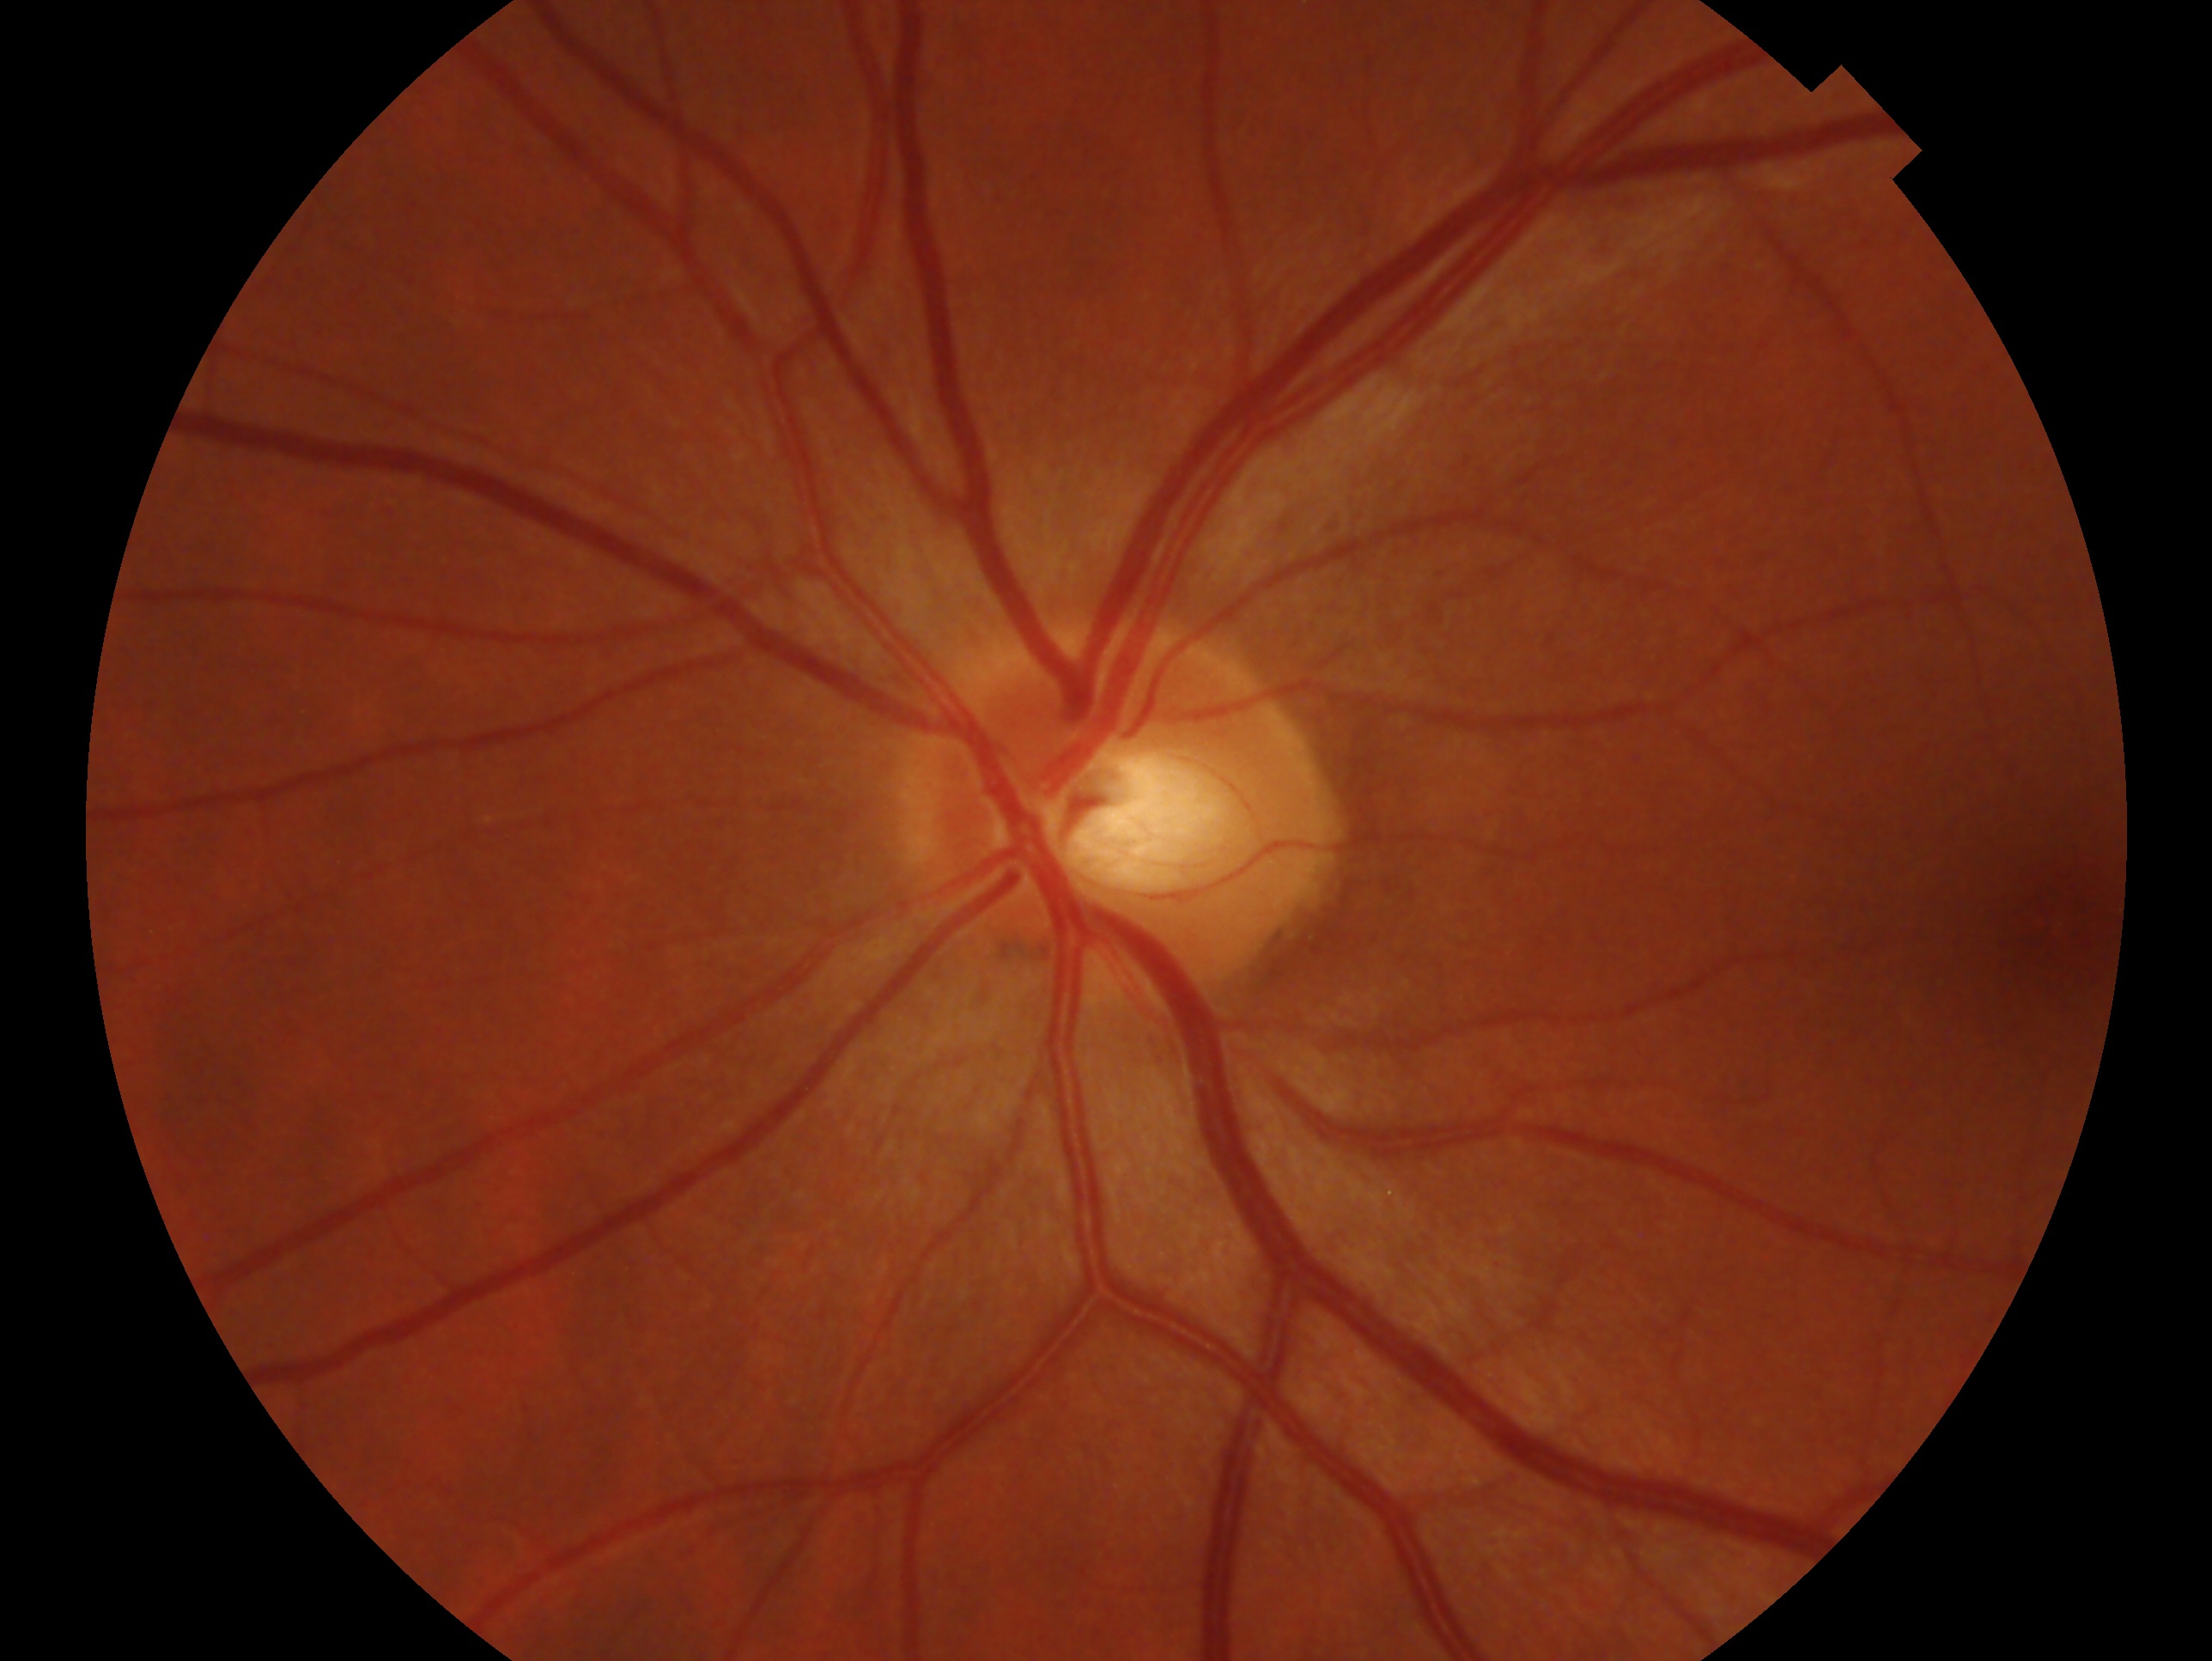 • laterality · left eye
• assessment · no glaucoma